Nonmydriatic; 45-degree field of view; 848 x 848 pixels; posterior pole color fundus photograph — 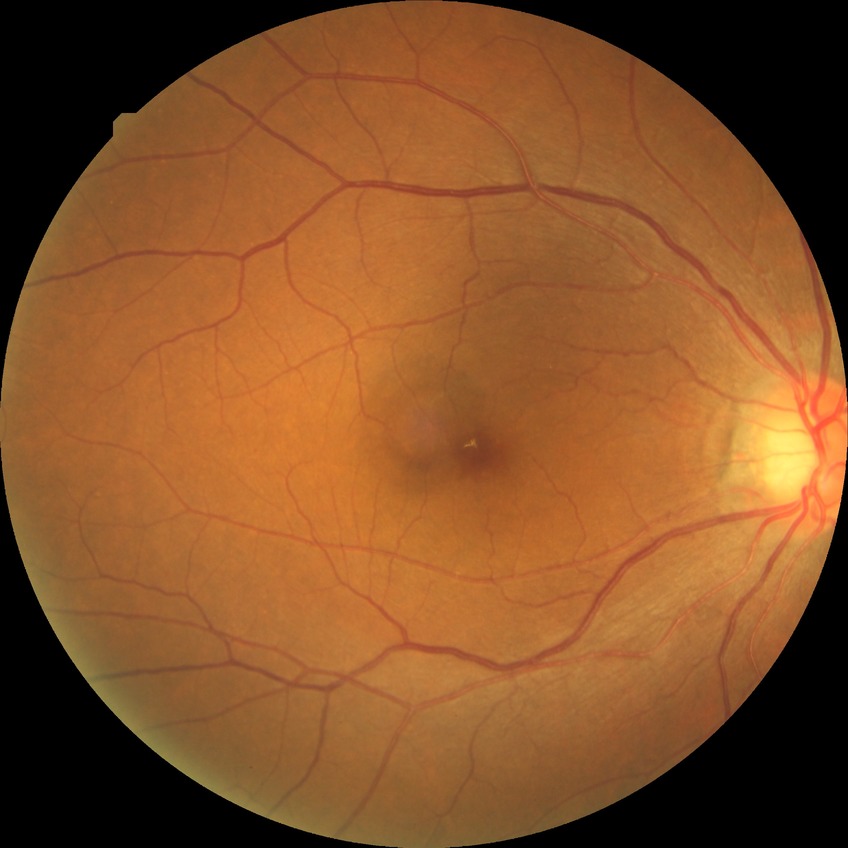

Davis grading@no diabetic retinopathy.